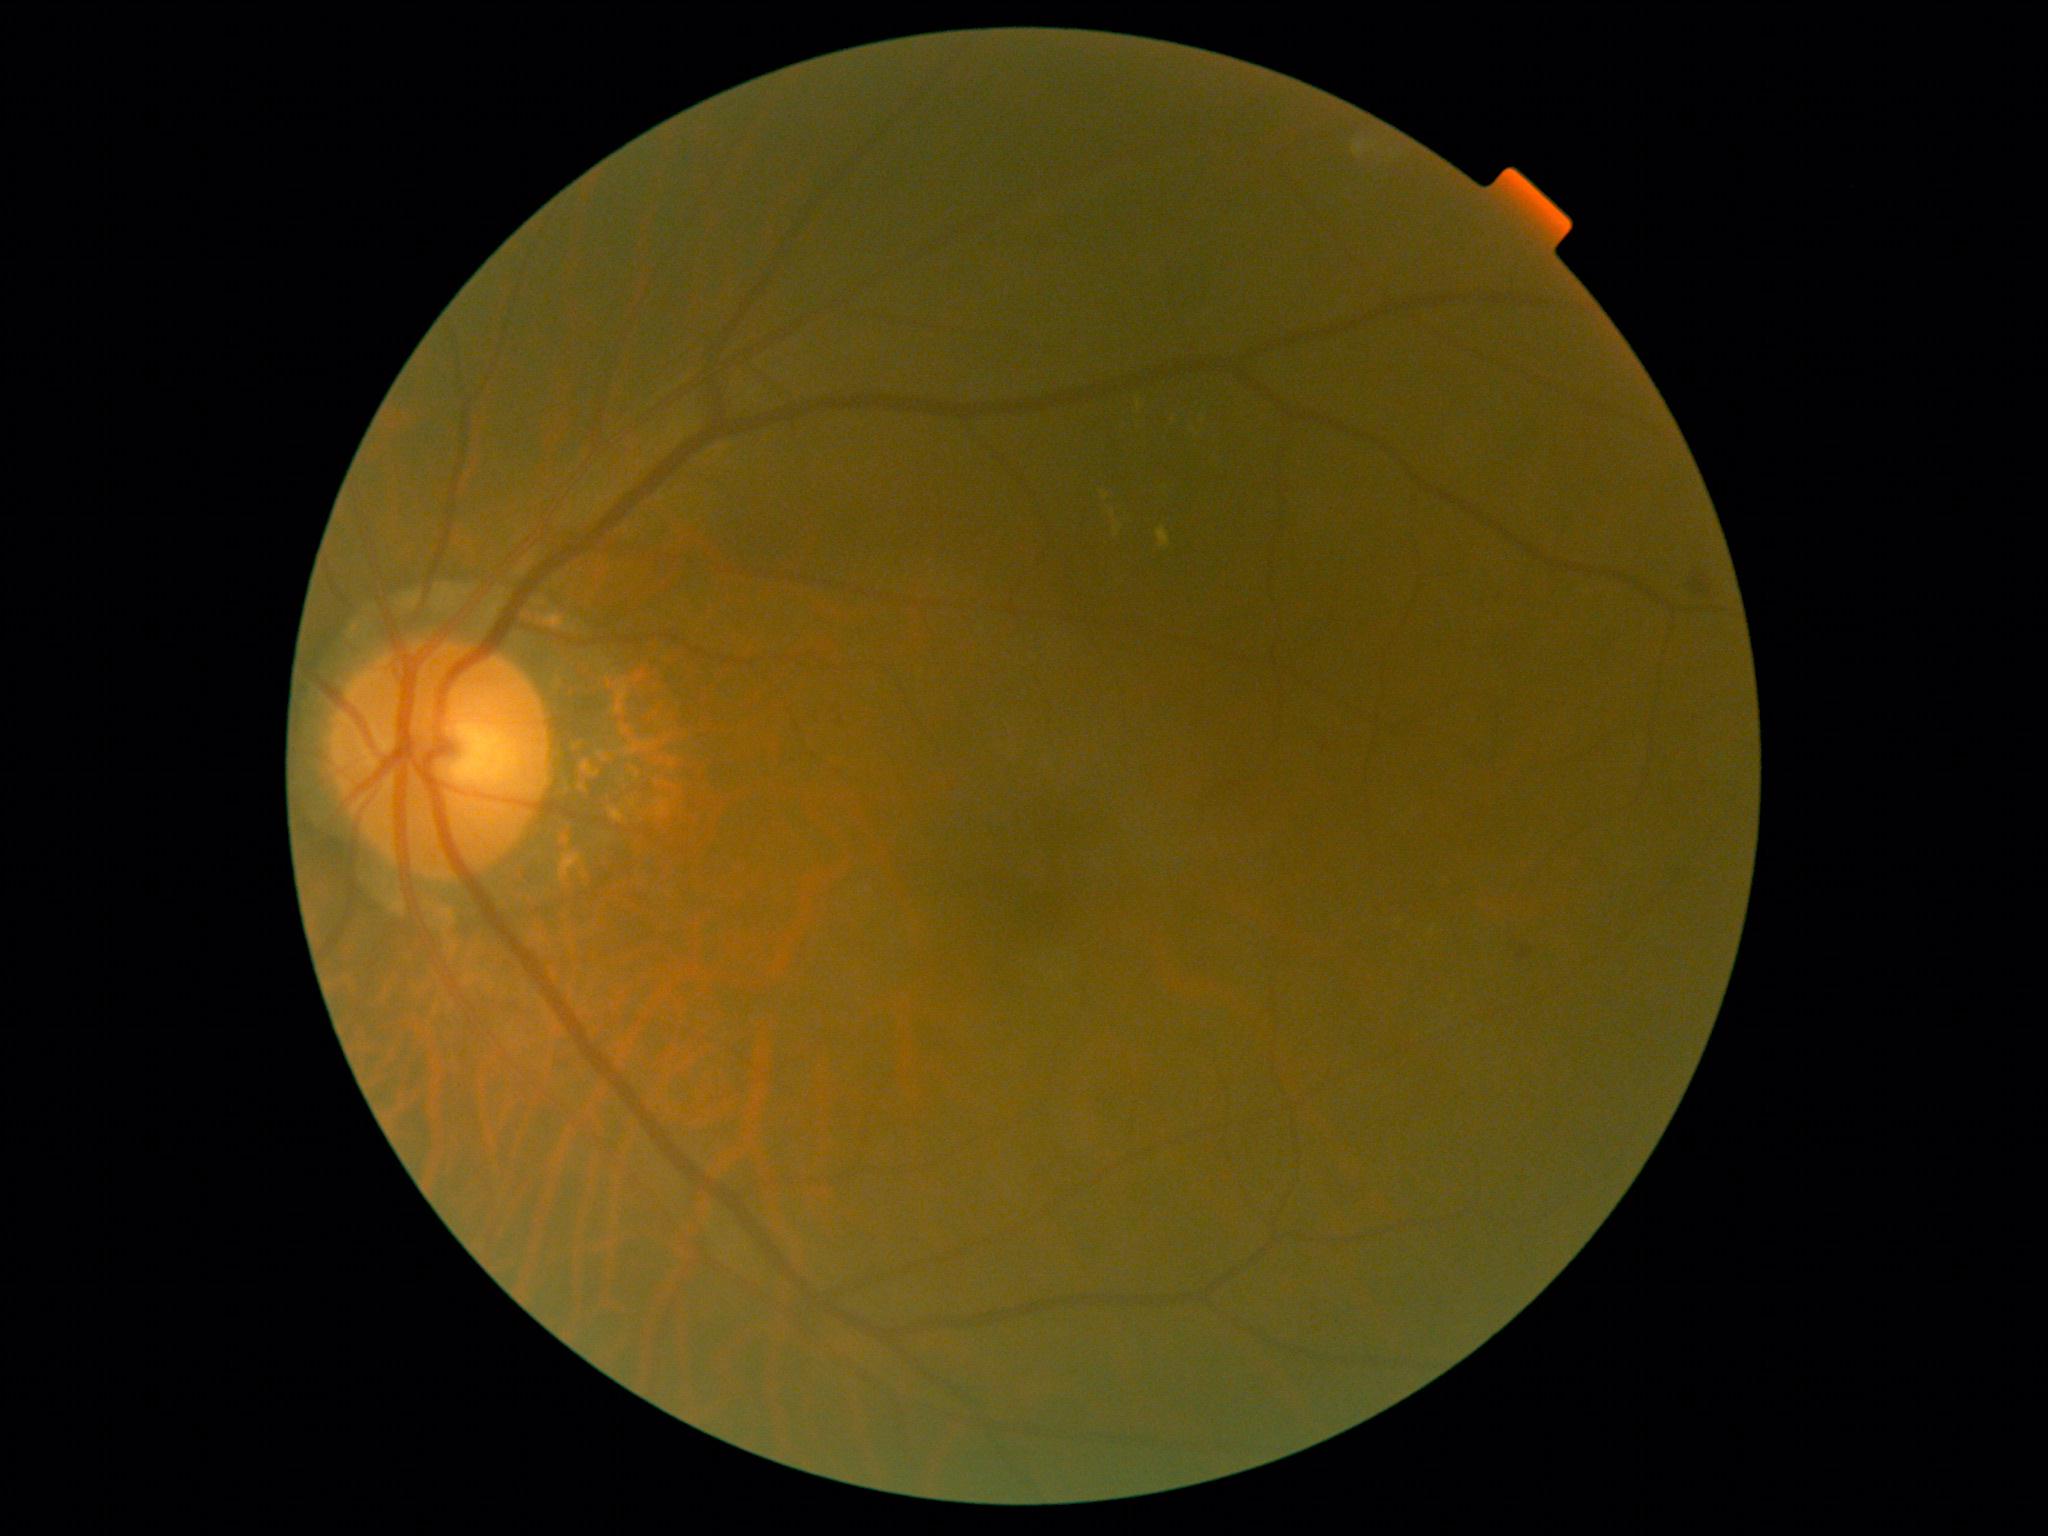 diabetic retinopathy severity@grade 2 (moderate NPDR) — more than just microaneurysms but less than severe NPDR.